Captured with the Clarity RetCam 3 (130° field of view). Wide-field fundus photograph of an infant:
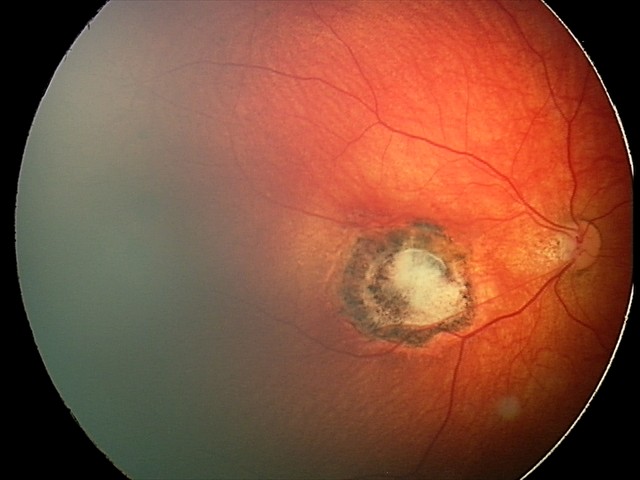

Screening series with toxoplasmosis chorioretinitis.